1659x2212; Remidio Fundus on Phone (FOP) camera:
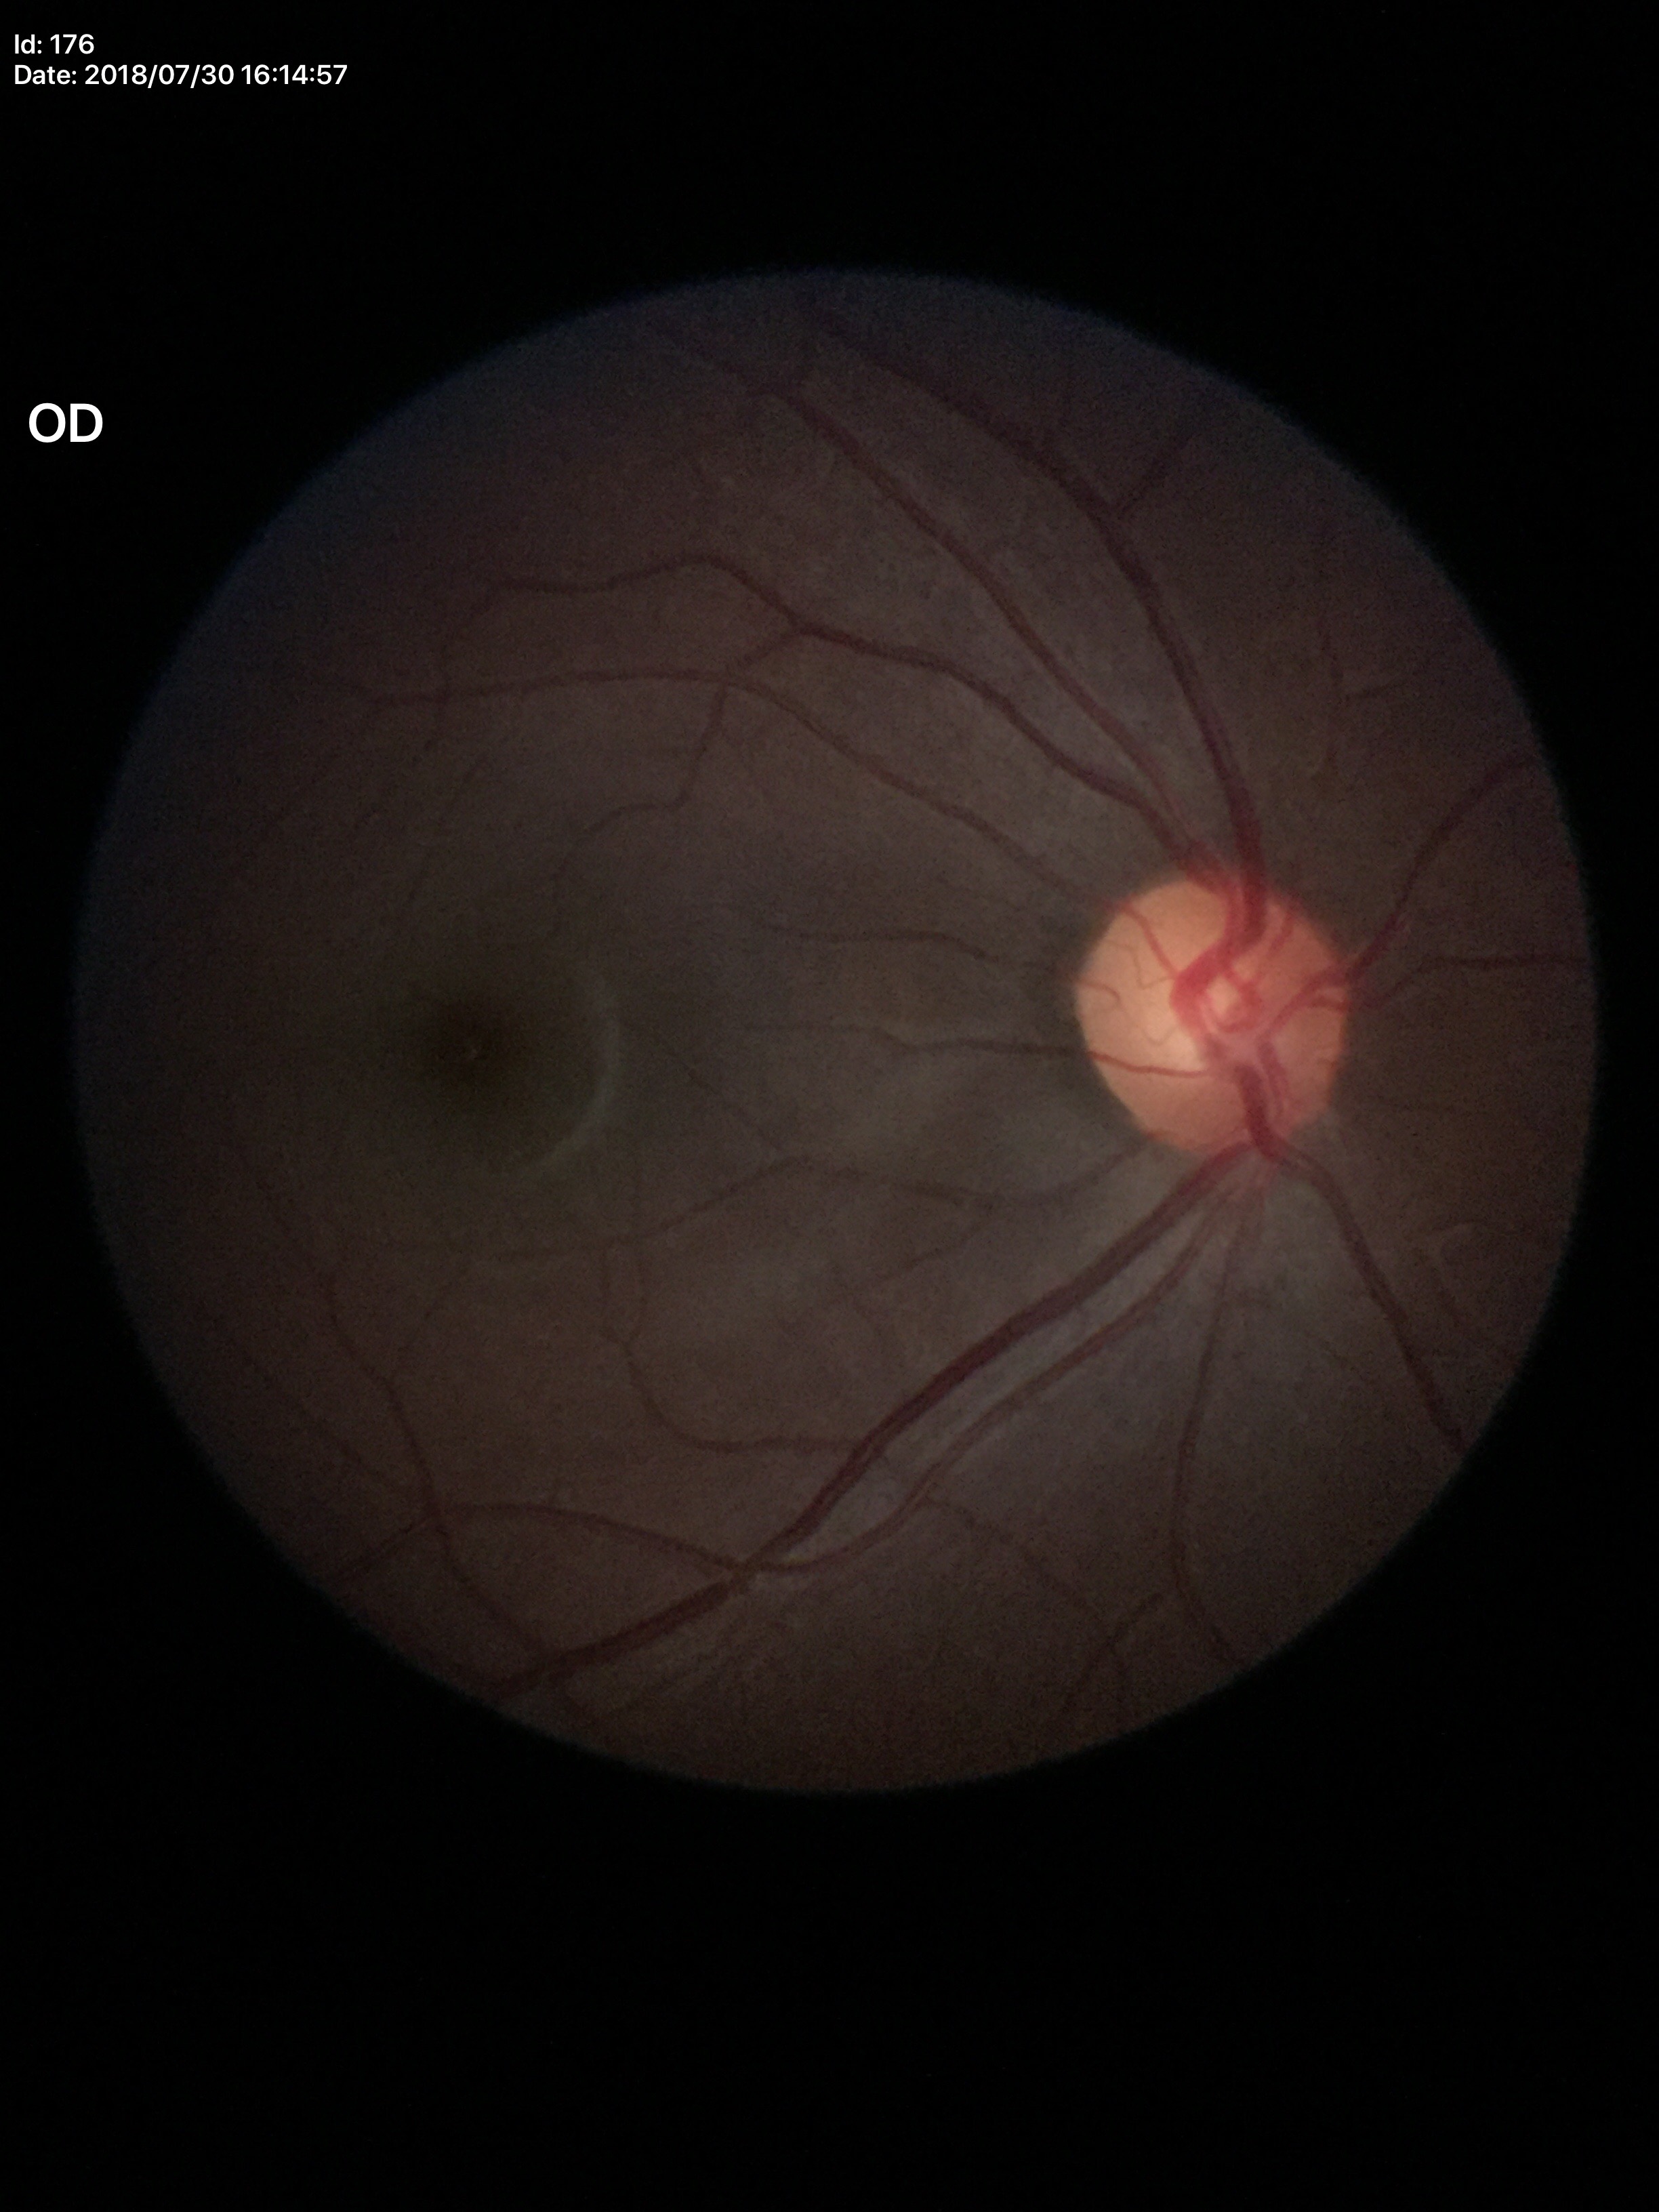 Not suspicious for glaucoma (5/5 ophthalmologists in agreement).
Area cup-to-disc ratio (ACDR) is 0.27.
Vertical C/D ratio (VCDR): 0.51.
Horizontal cup-disc ratio (HCDR) of 0.52.